848x848 · no pharmacologic dilation · NIDEK AFC-230 · 45 degree fundus photograph
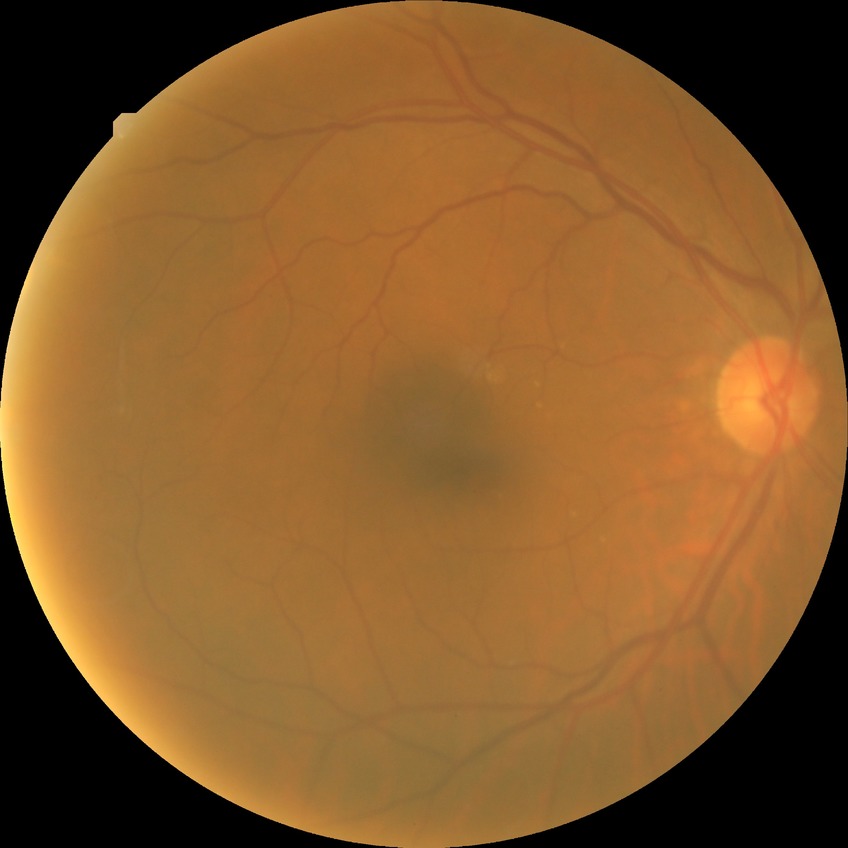
Annotations:
- diabetic retinopathy stage: no diabetic retinopathy